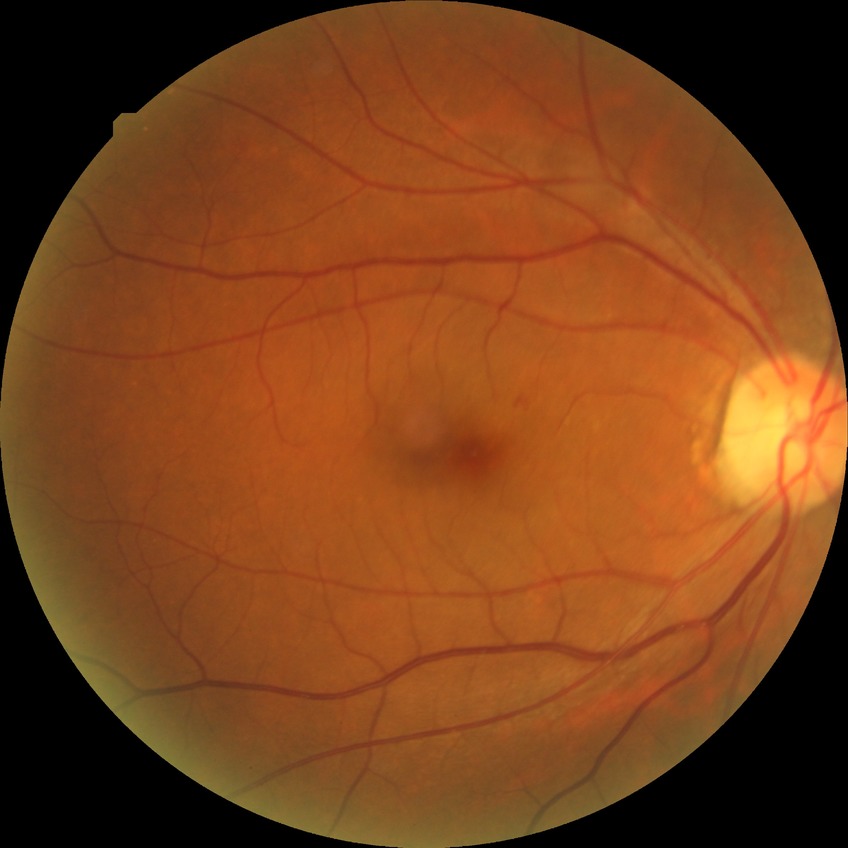 - DR class — non-proliferative diabetic retinopathy
- Davis grading — simple diabetic retinopathy